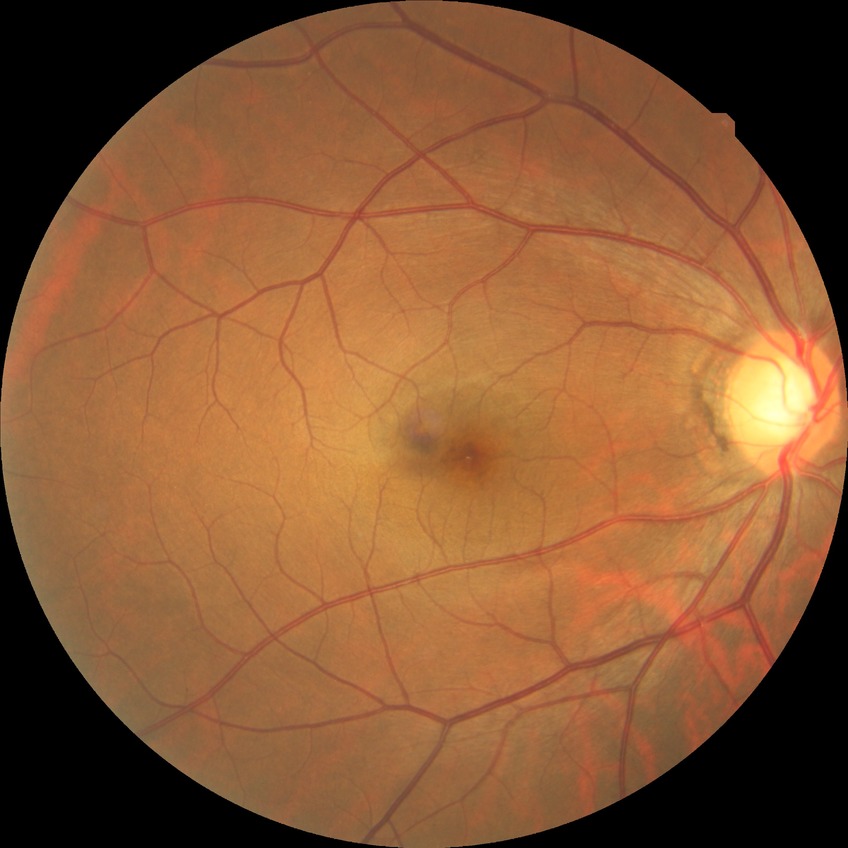

Retinopathy grade: no diabetic retinopathy.